Color fundus photograph
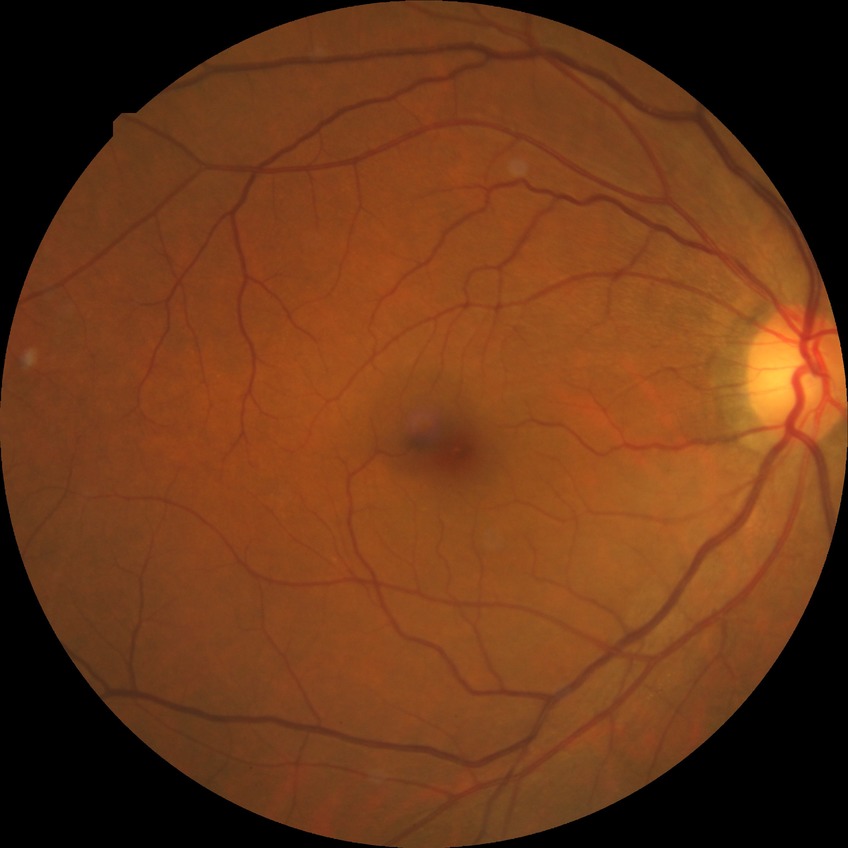 {
  "dr_impression": "no apparent DR",
  "davis_grade": "NDR"
}